45° field of view · fundus photo · 1932 x 1932 pixels
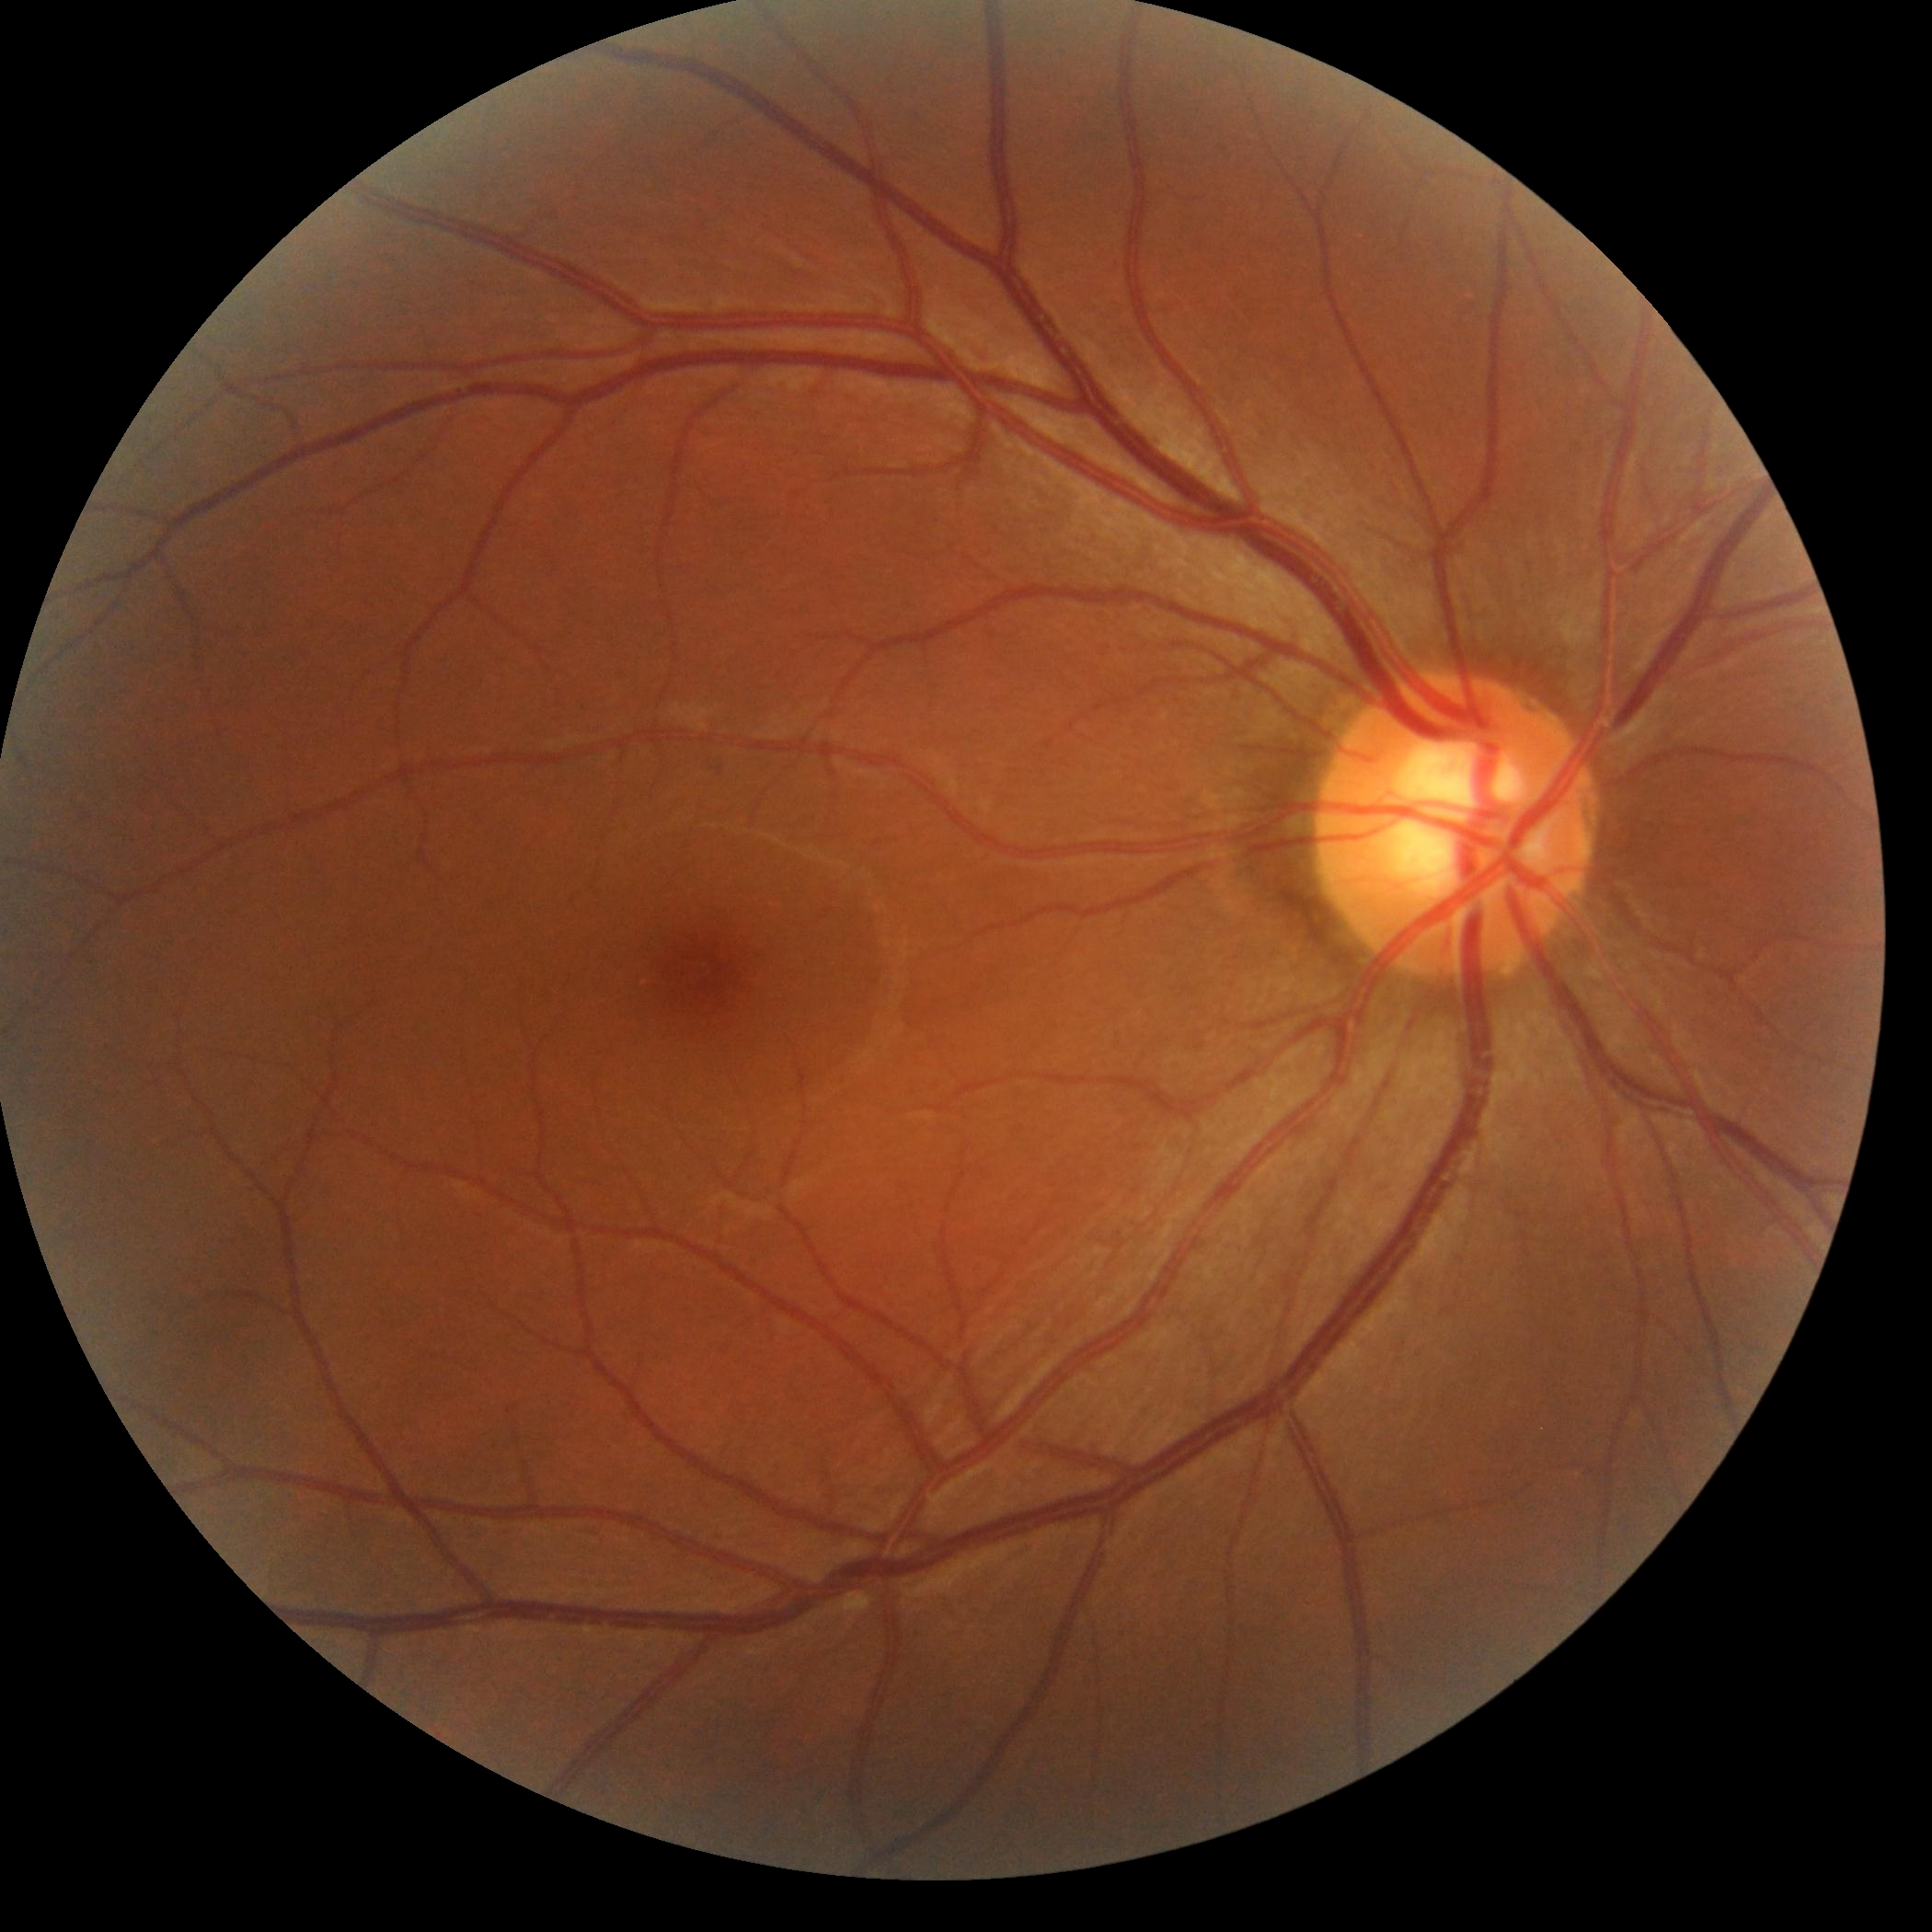
{"dr_impression": "no apparent DR", "dr_grade": "grade 0 — no visible signs of diabetic retinopathy"}